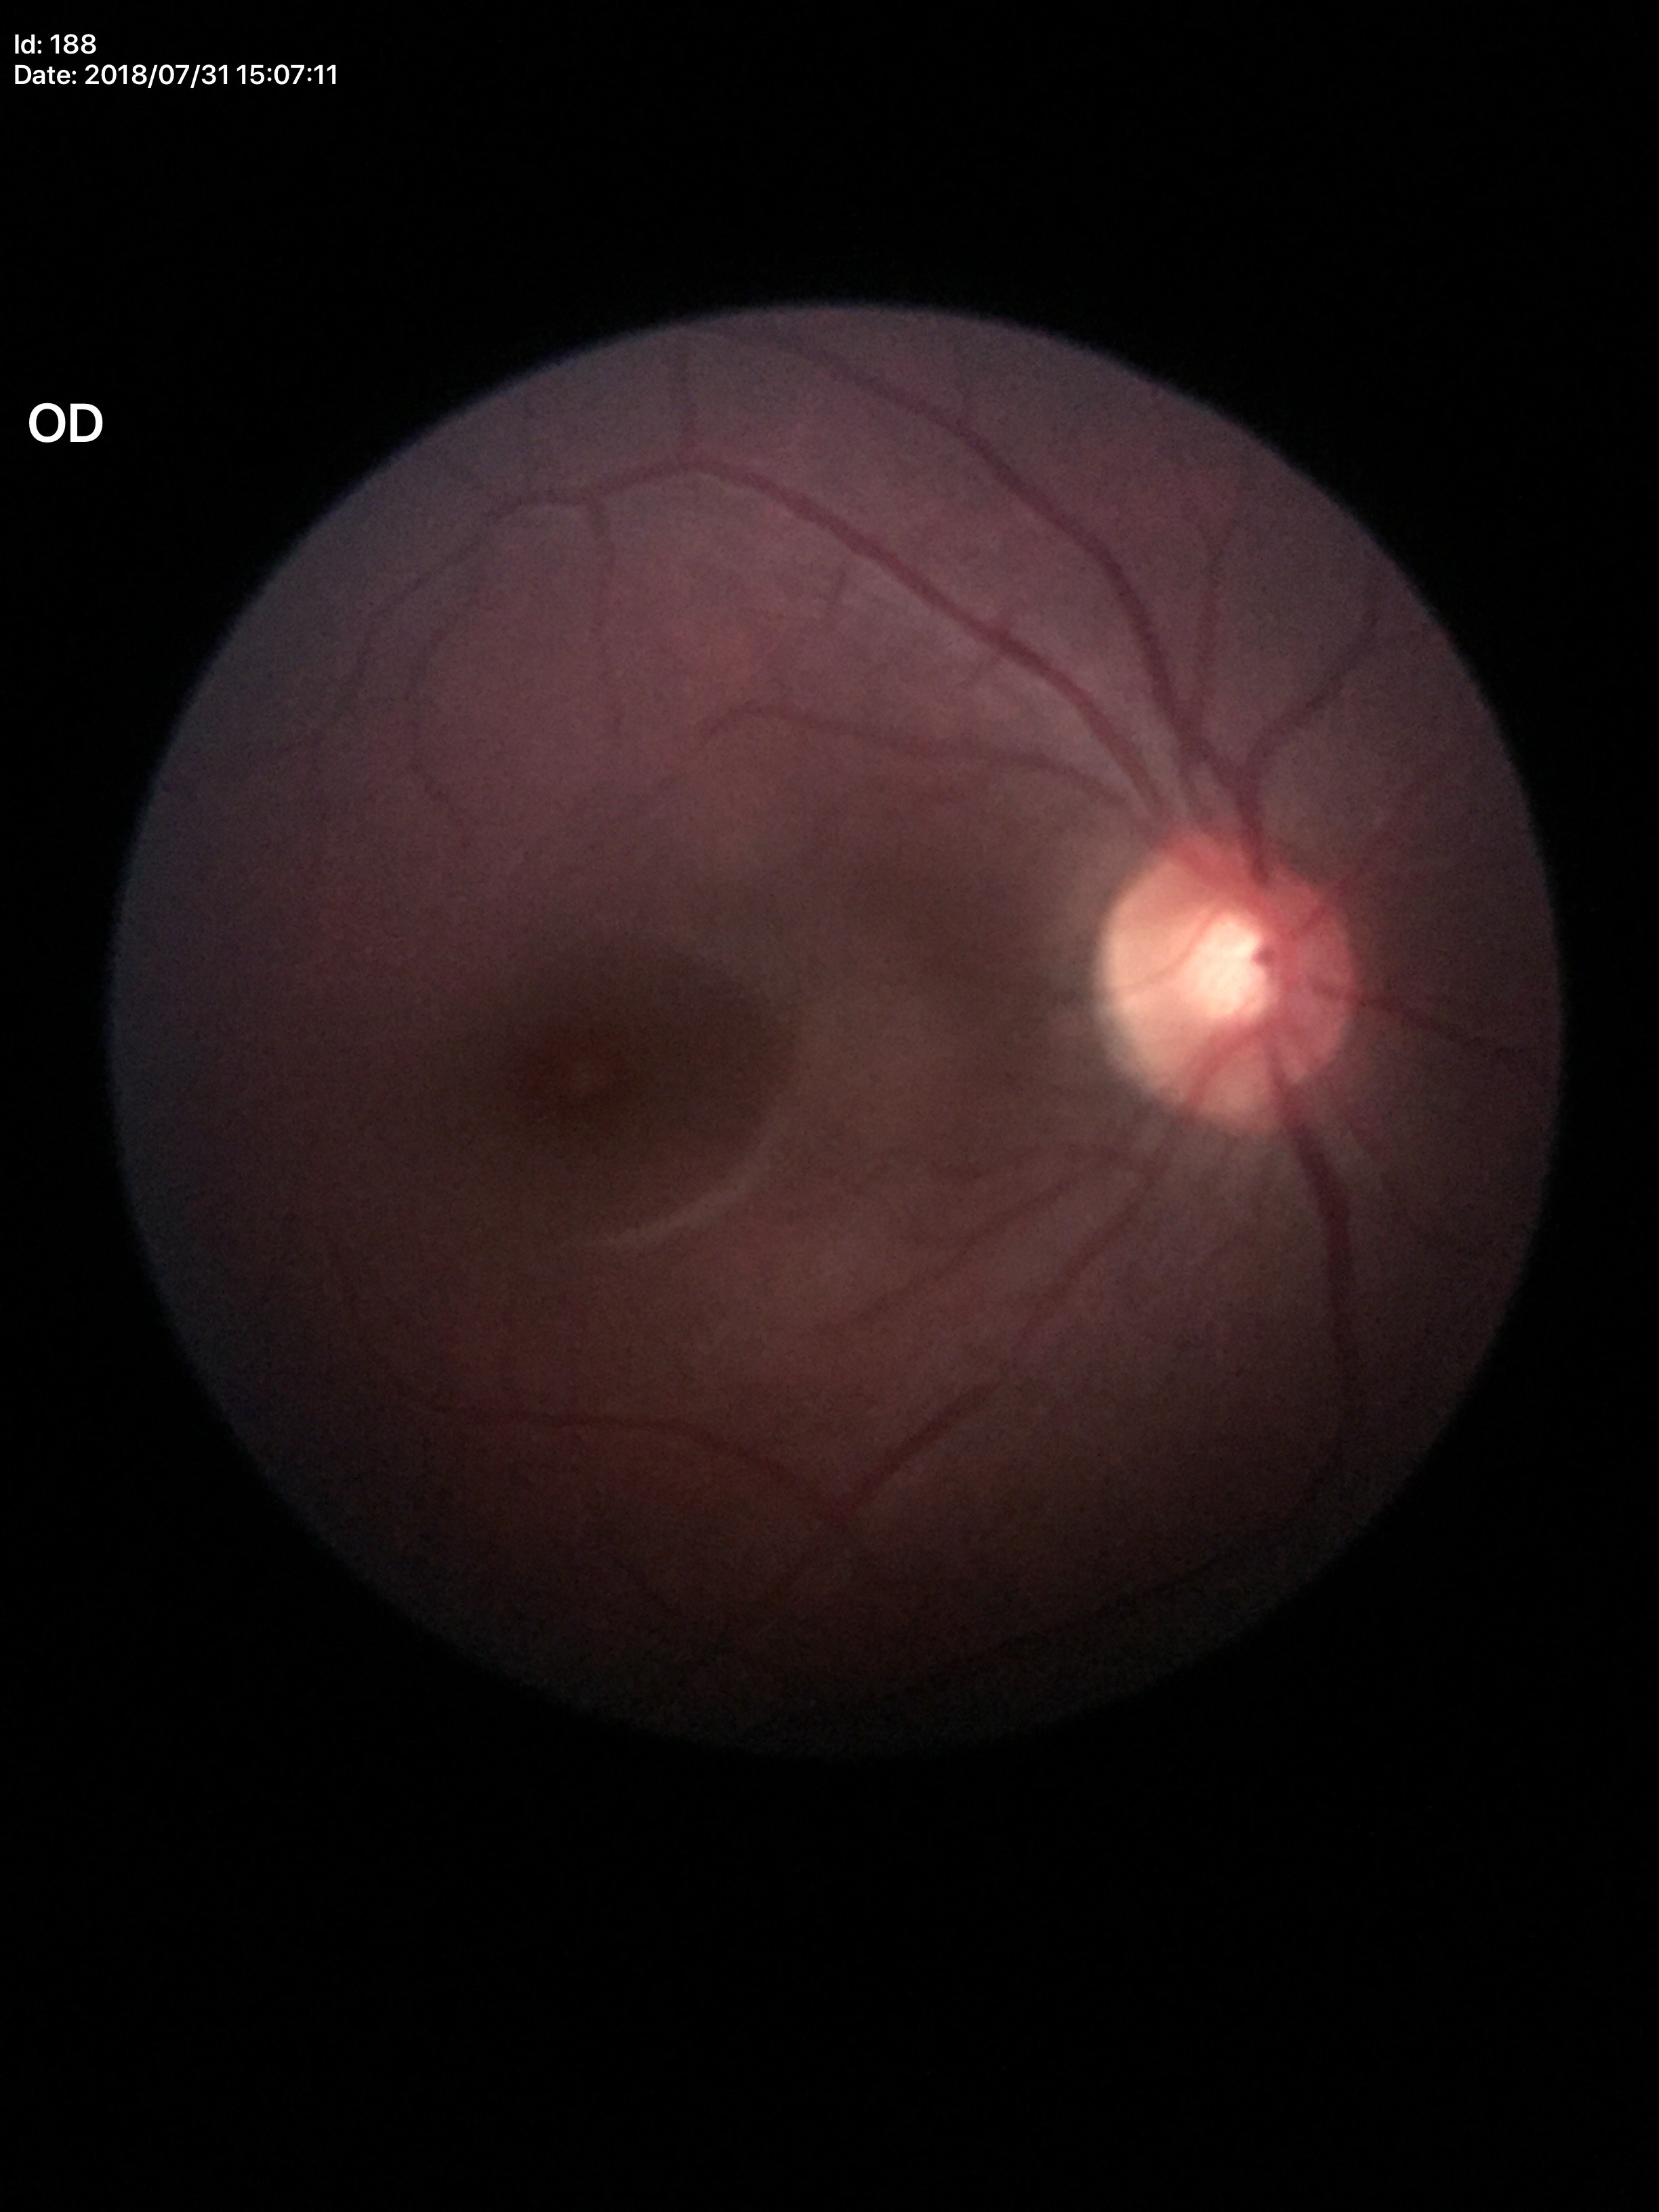 Glaucoma evaluation: not suspect (5/5 ophthalmologists in agreement). Vertical cup-to-disc ratio is 0.51.